Color fundus image, image size 2048x1536, 45° FOV.
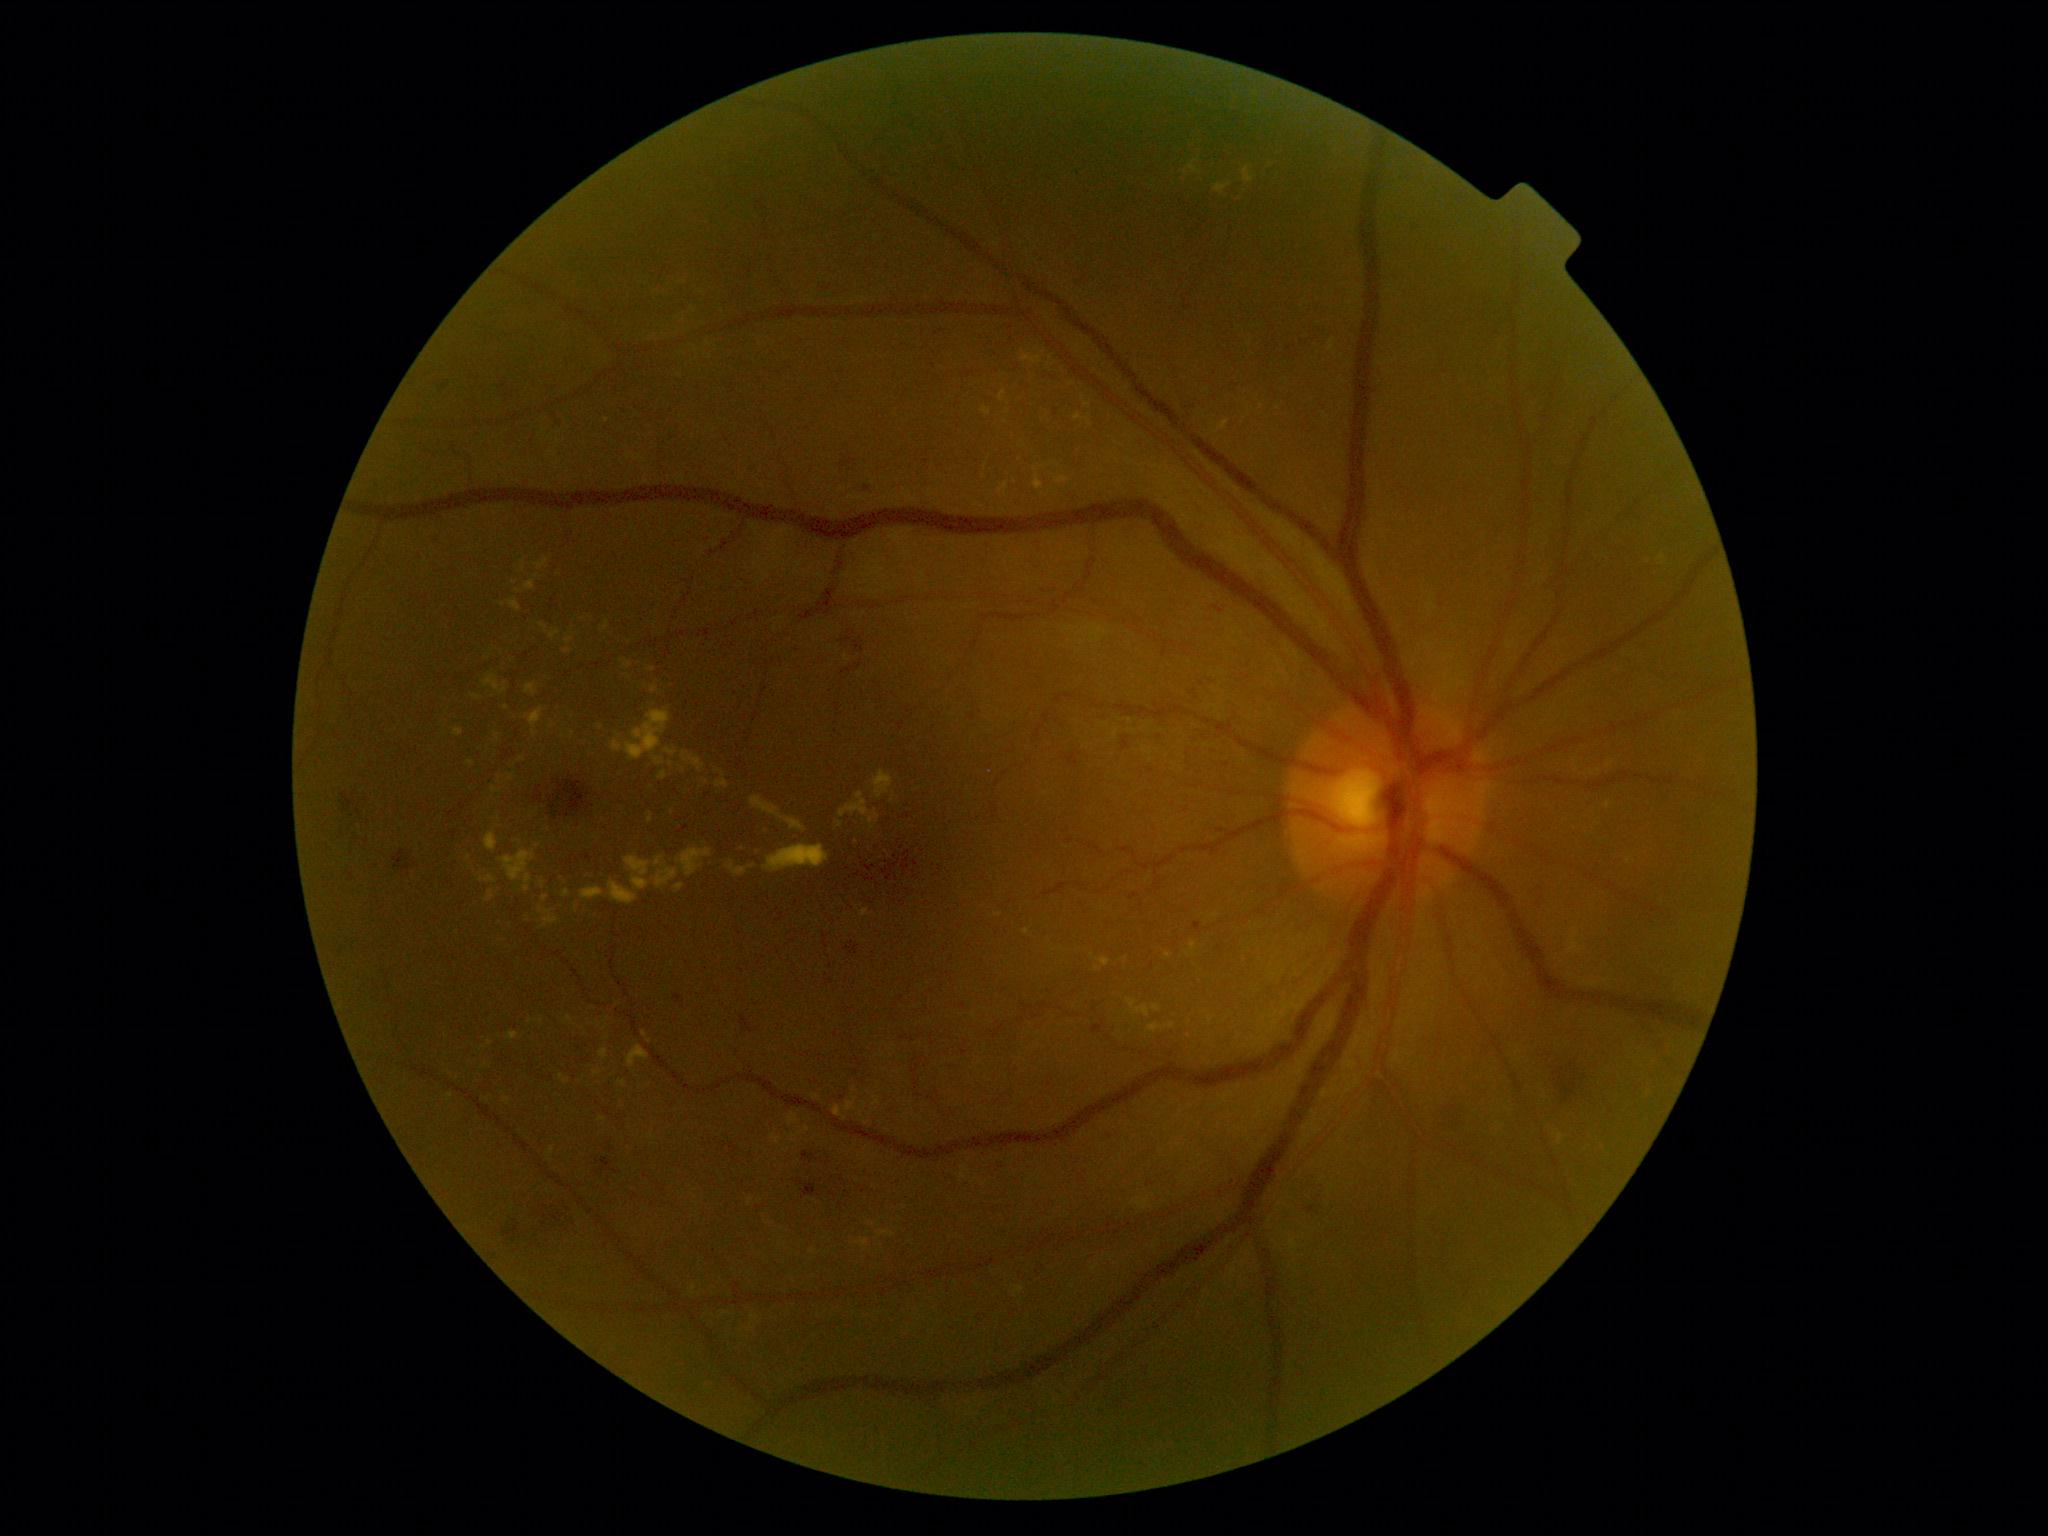 Diabetic retinopathy (DR) is grade 2 (moderate NPDR).
Hard exudates (EXs) are present, including at (1329,338,1336,352) | (1014,1286,1024,1299) | (485,891,495,902) | (648,812,654,823) | (618,1081,627,1087) | (651,686,660,694) | (508,599,521,611) | (726,861,757,878) | (840,792,880,832) | (485,832,499,852).
Small EXs approximately at (490; 1044) | (864; 1104) | (545; 898) | (1026; 932) | (1098; 969) | (550; 727) | (507; 708) | (1189; 1036).